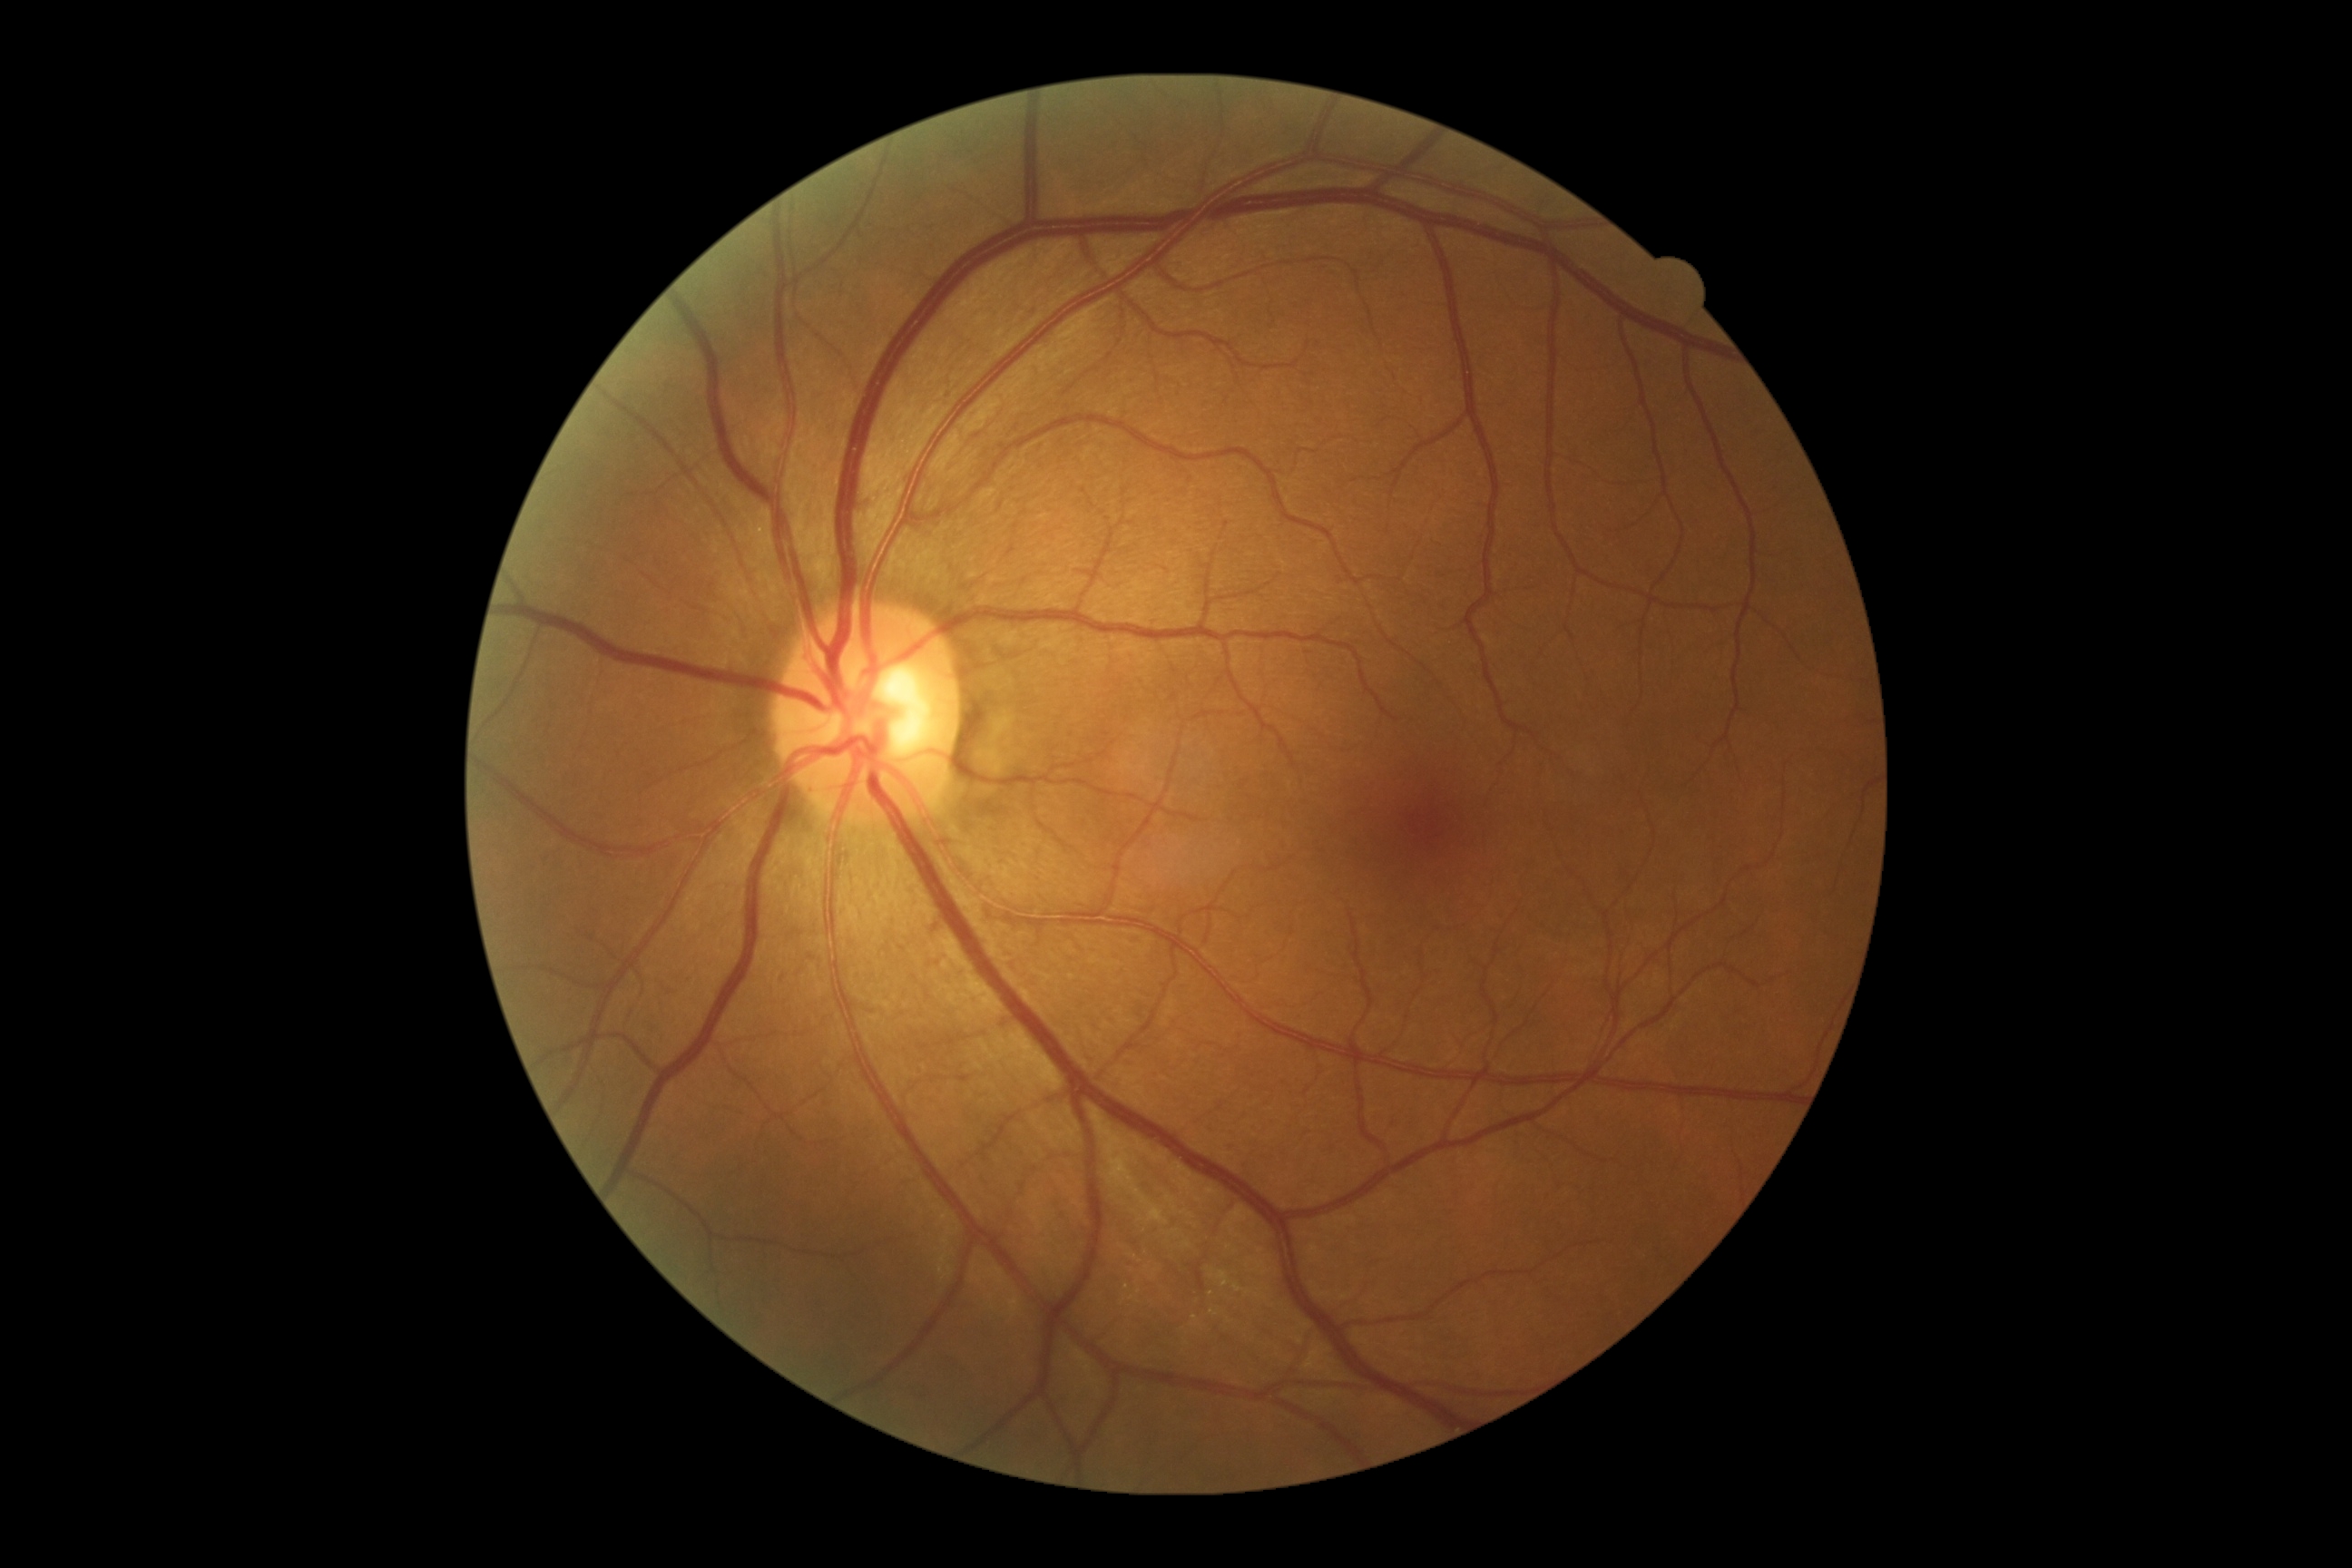 No diabetic retinal disease findings. Diabetic retinopathy (DR) is grade 0 (no apparent retinopathy).